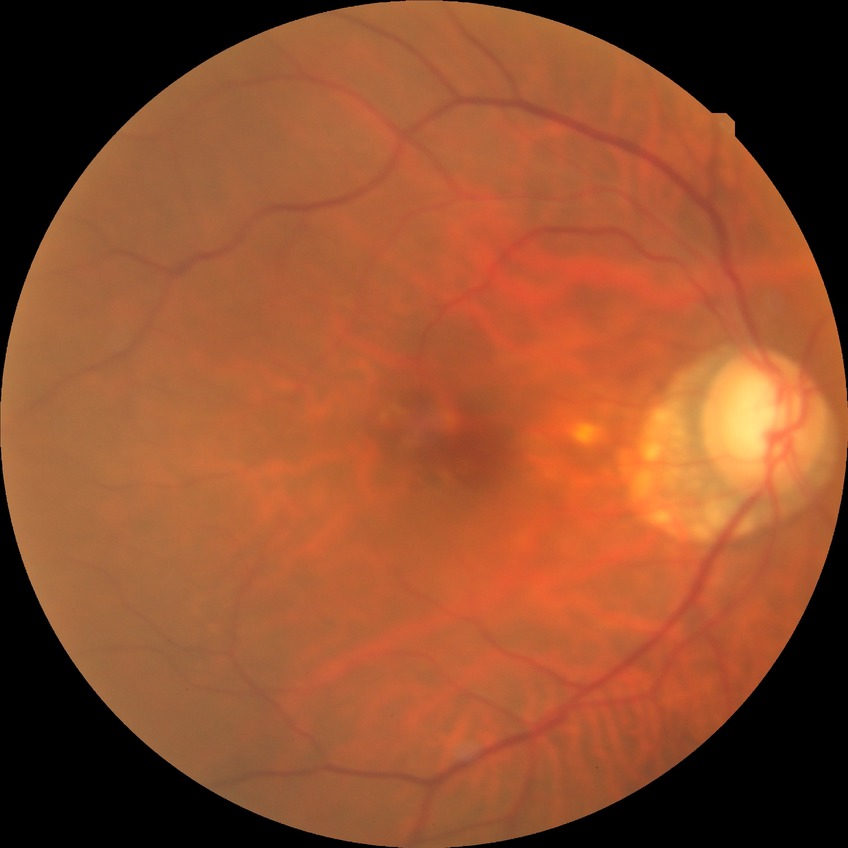
Modified Davis classification: no diabetic retinopathy.